45 degree fundus photograph, no pharmacologic dilation, color fundus photograph, 848x848px
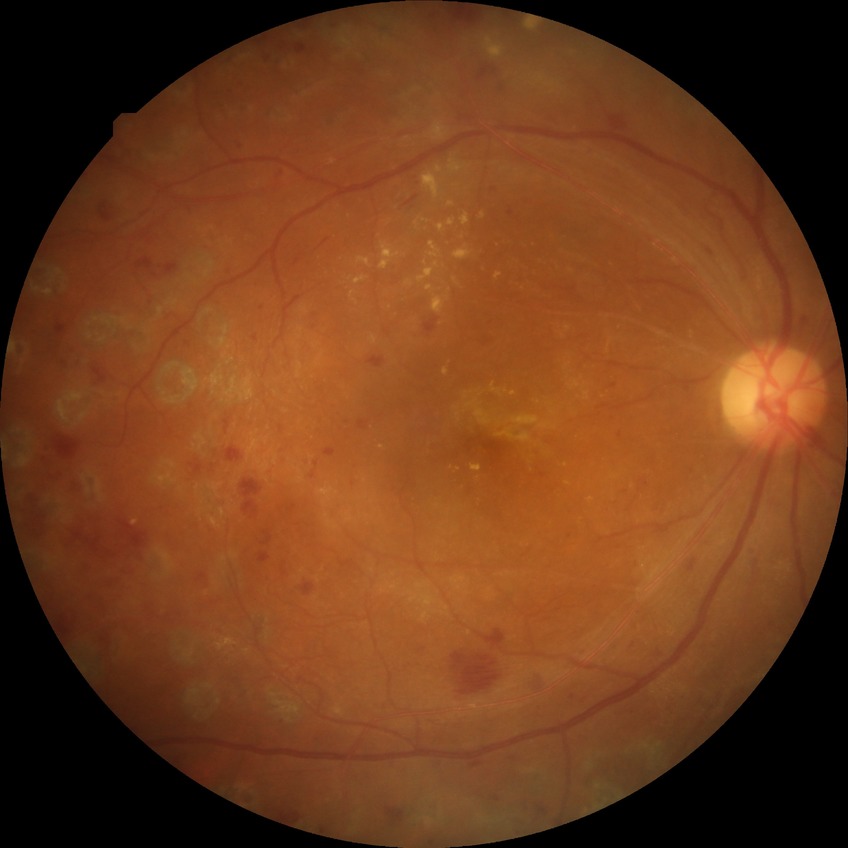
{
  "davis_grade": "proliferative diabetic retinopathy (PDR)"
}